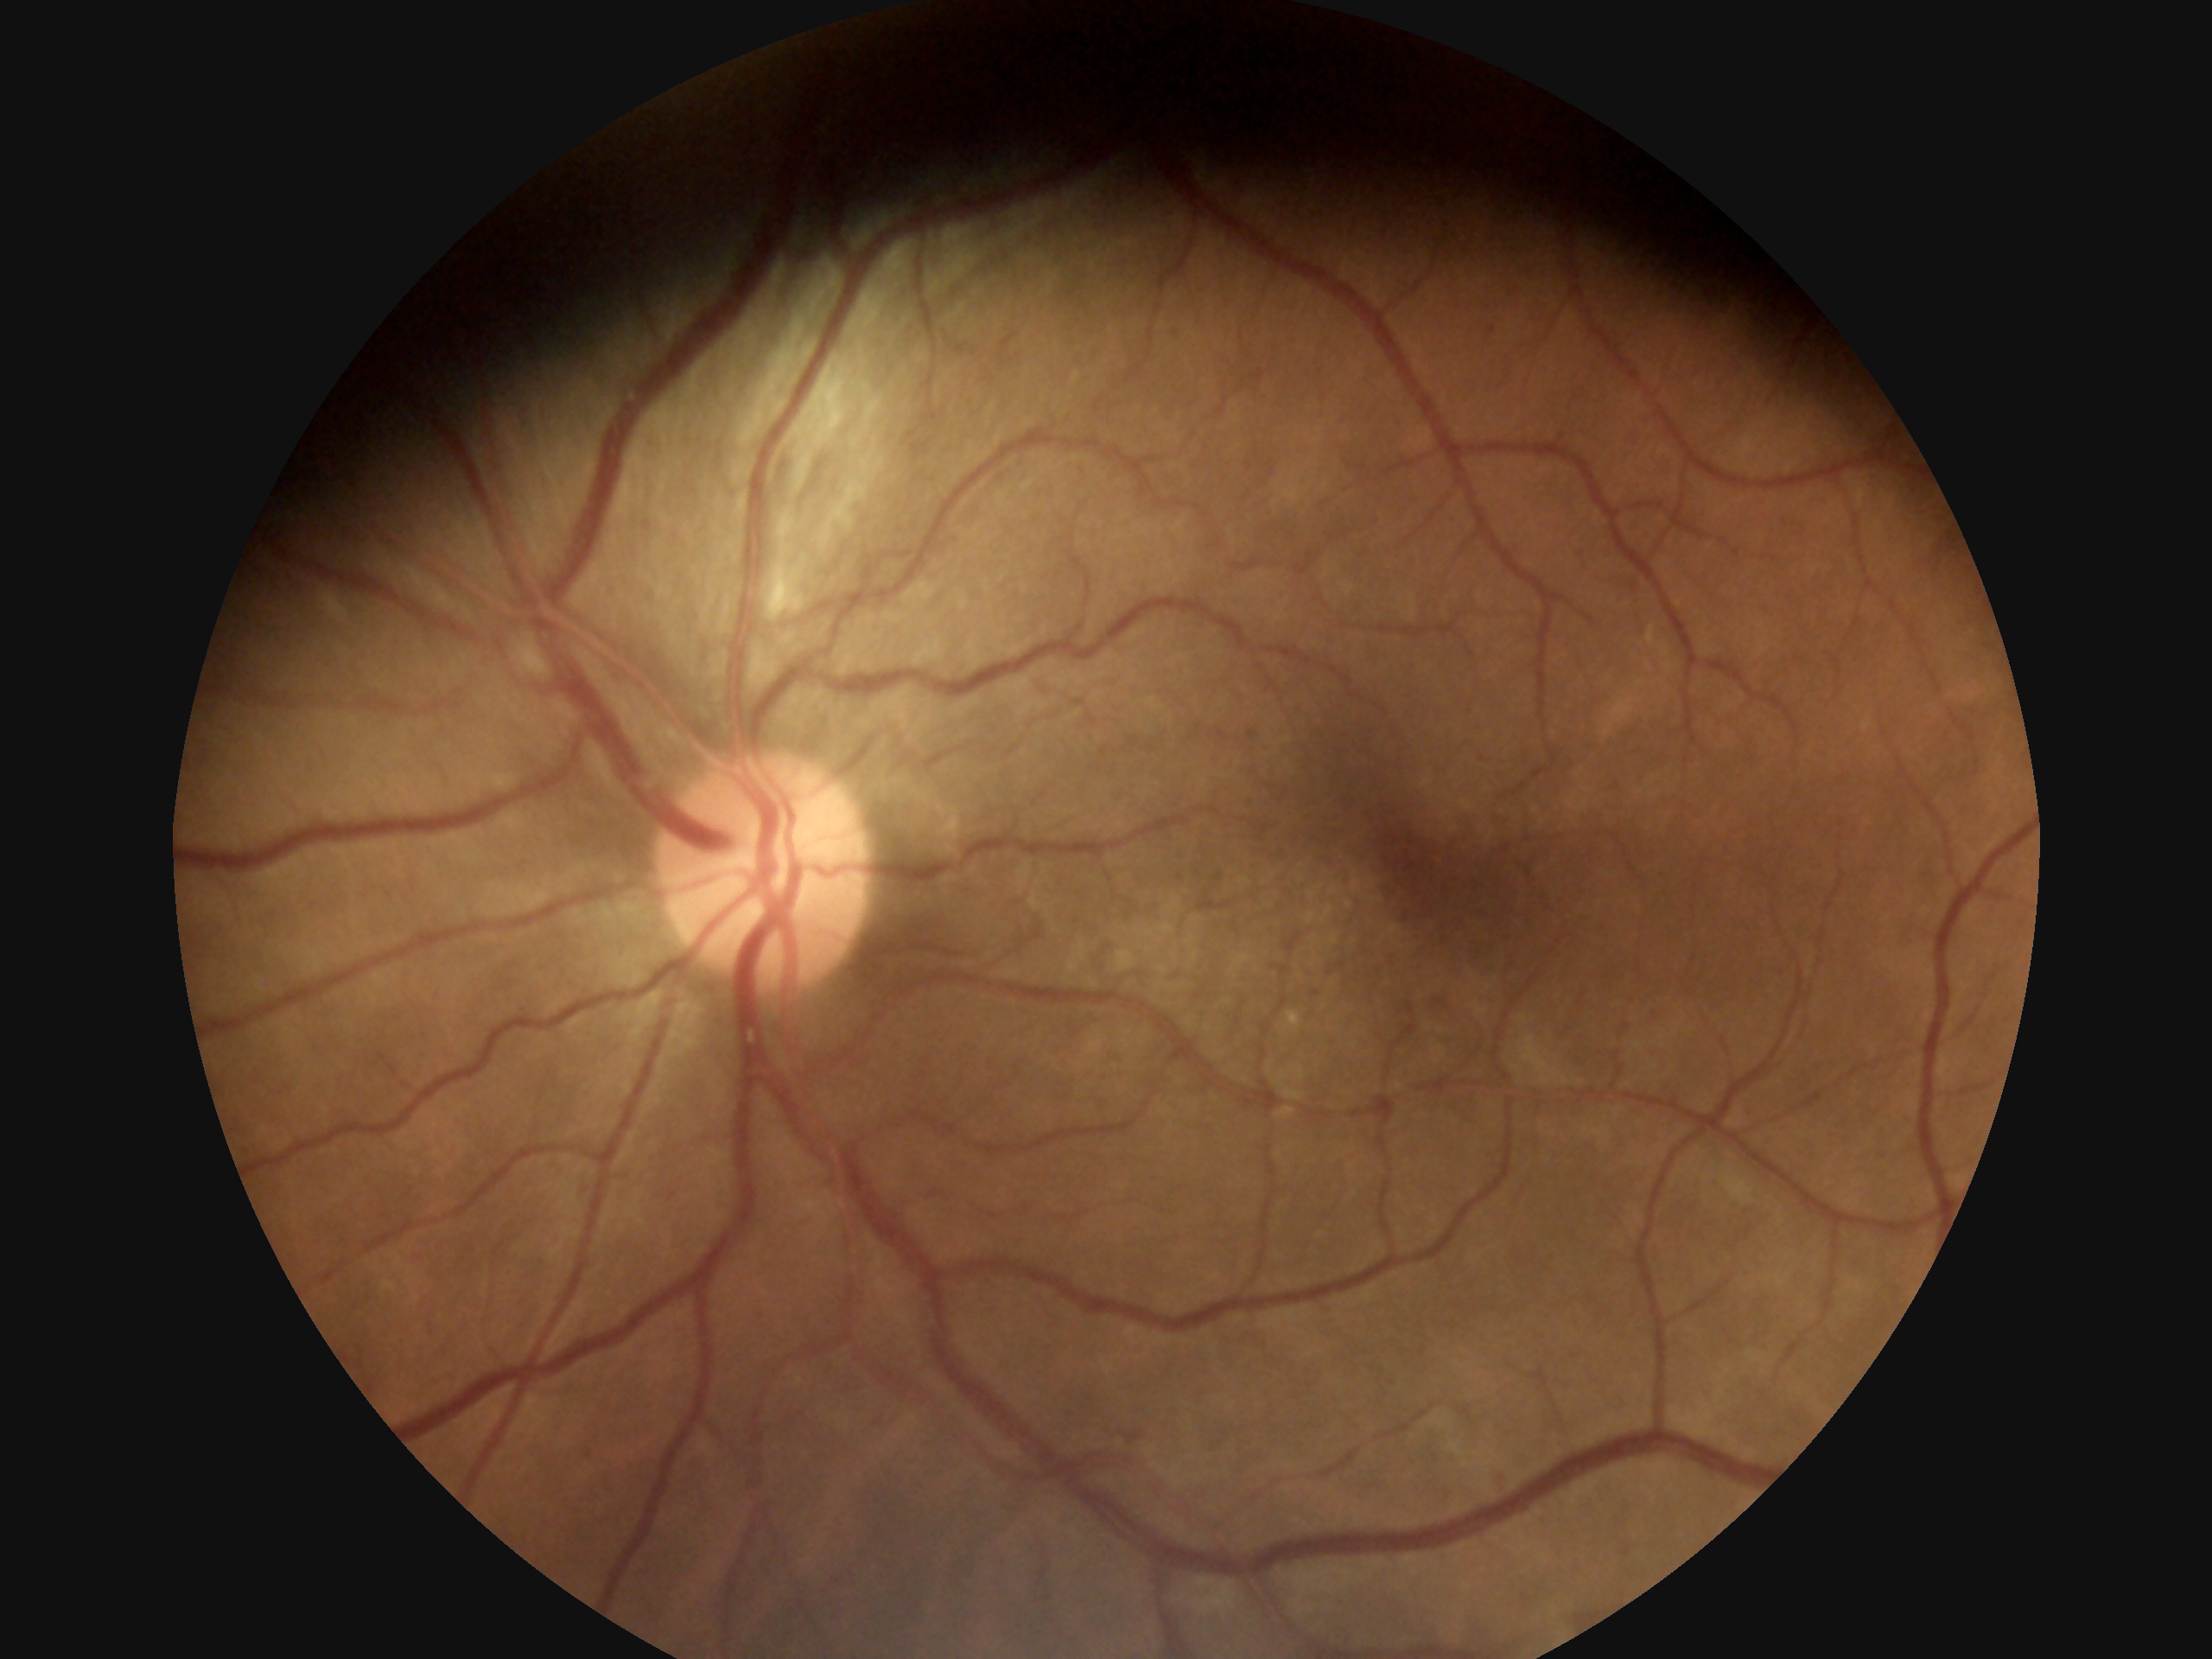 Diabetic retinopathy: 2/4.